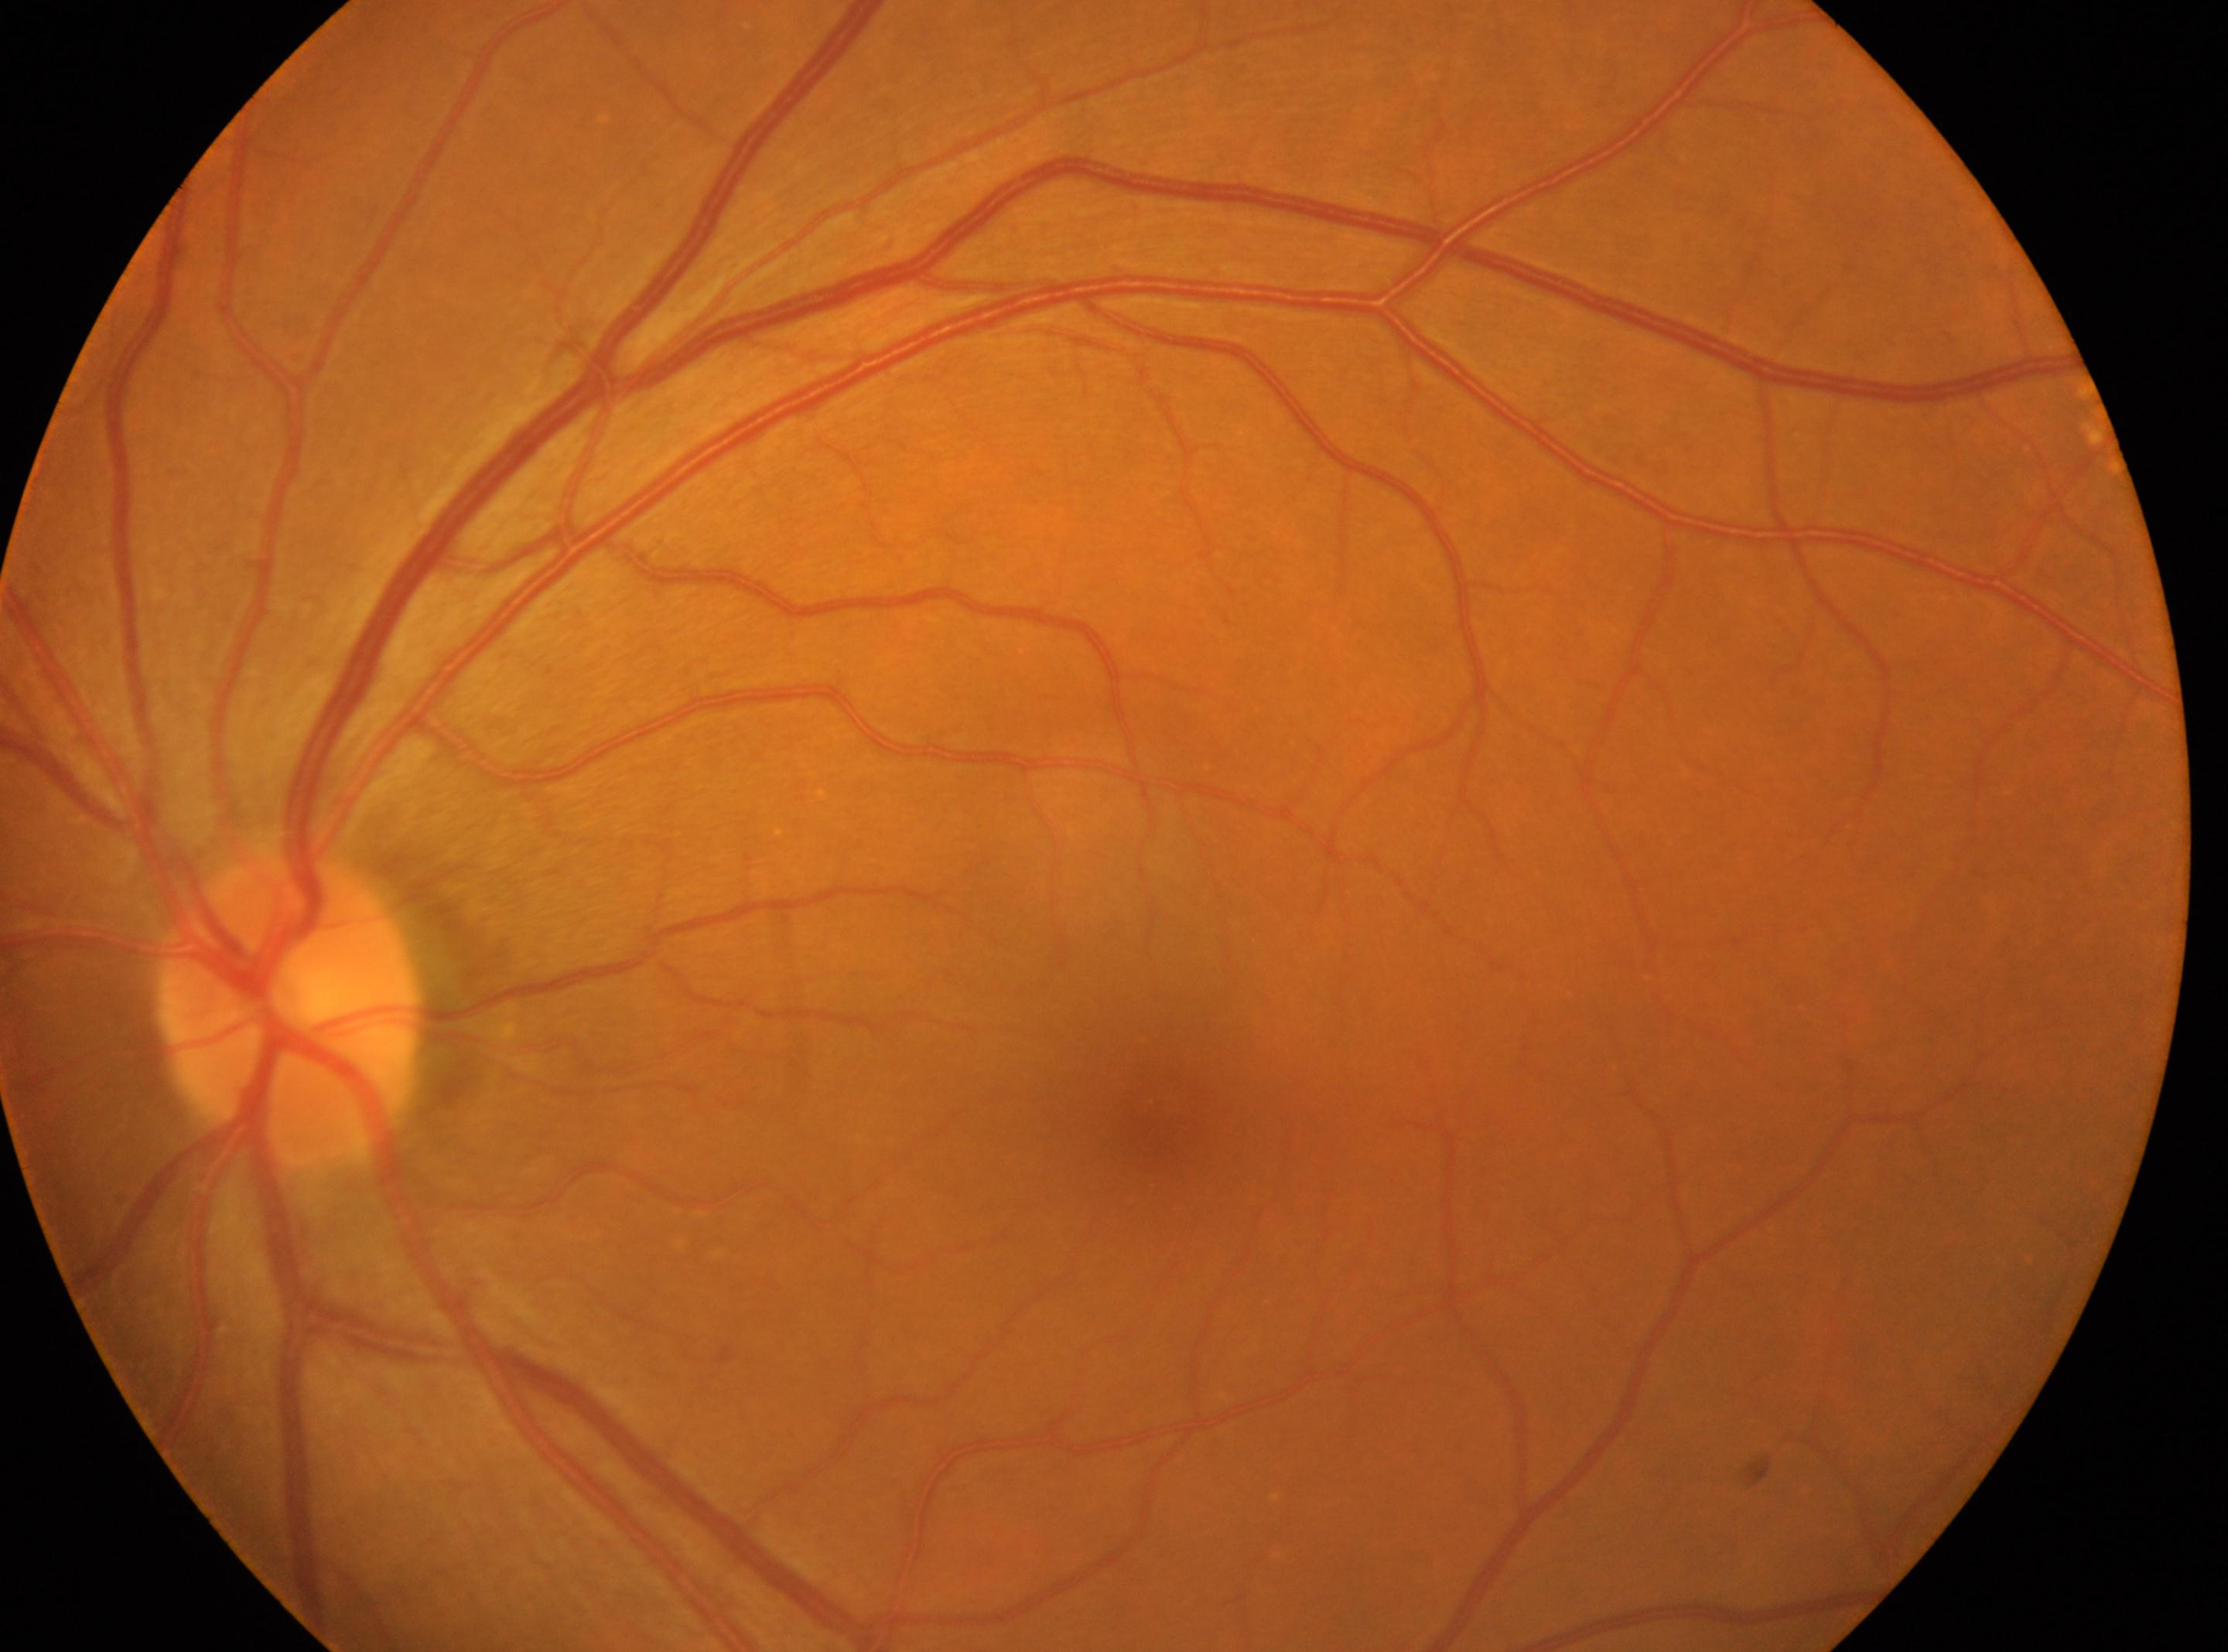
Eye: left eye. No DR findings. The macular center is at x=1156, y=1112. Disc center located at x=286, y=1006. DR grade: 0 (no apparent retinopathy) — no visible signs of diabetic retinopathy.